Non-mydriatic fundus camera
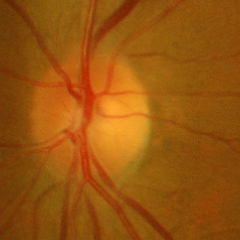

Glaucomatous changes are present. Diagnosis: early glaucomatous optic neuropathy.